Modified Davis grading: 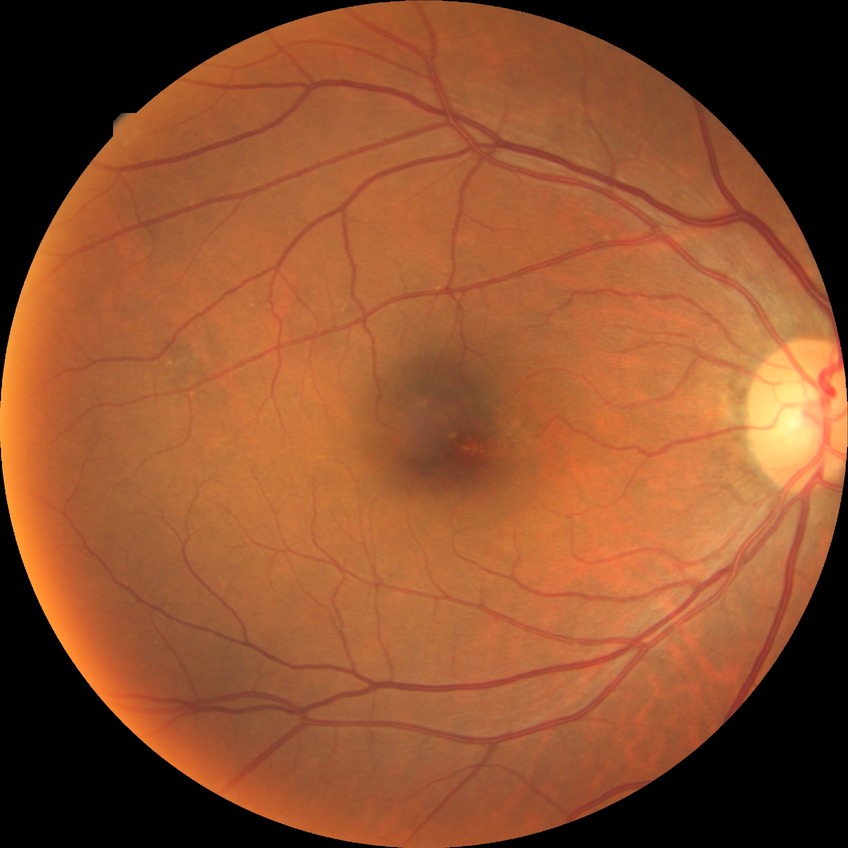

Davis grade is NDR.